45° FOV. 2352 by 1568 pixels. Color fundus image.
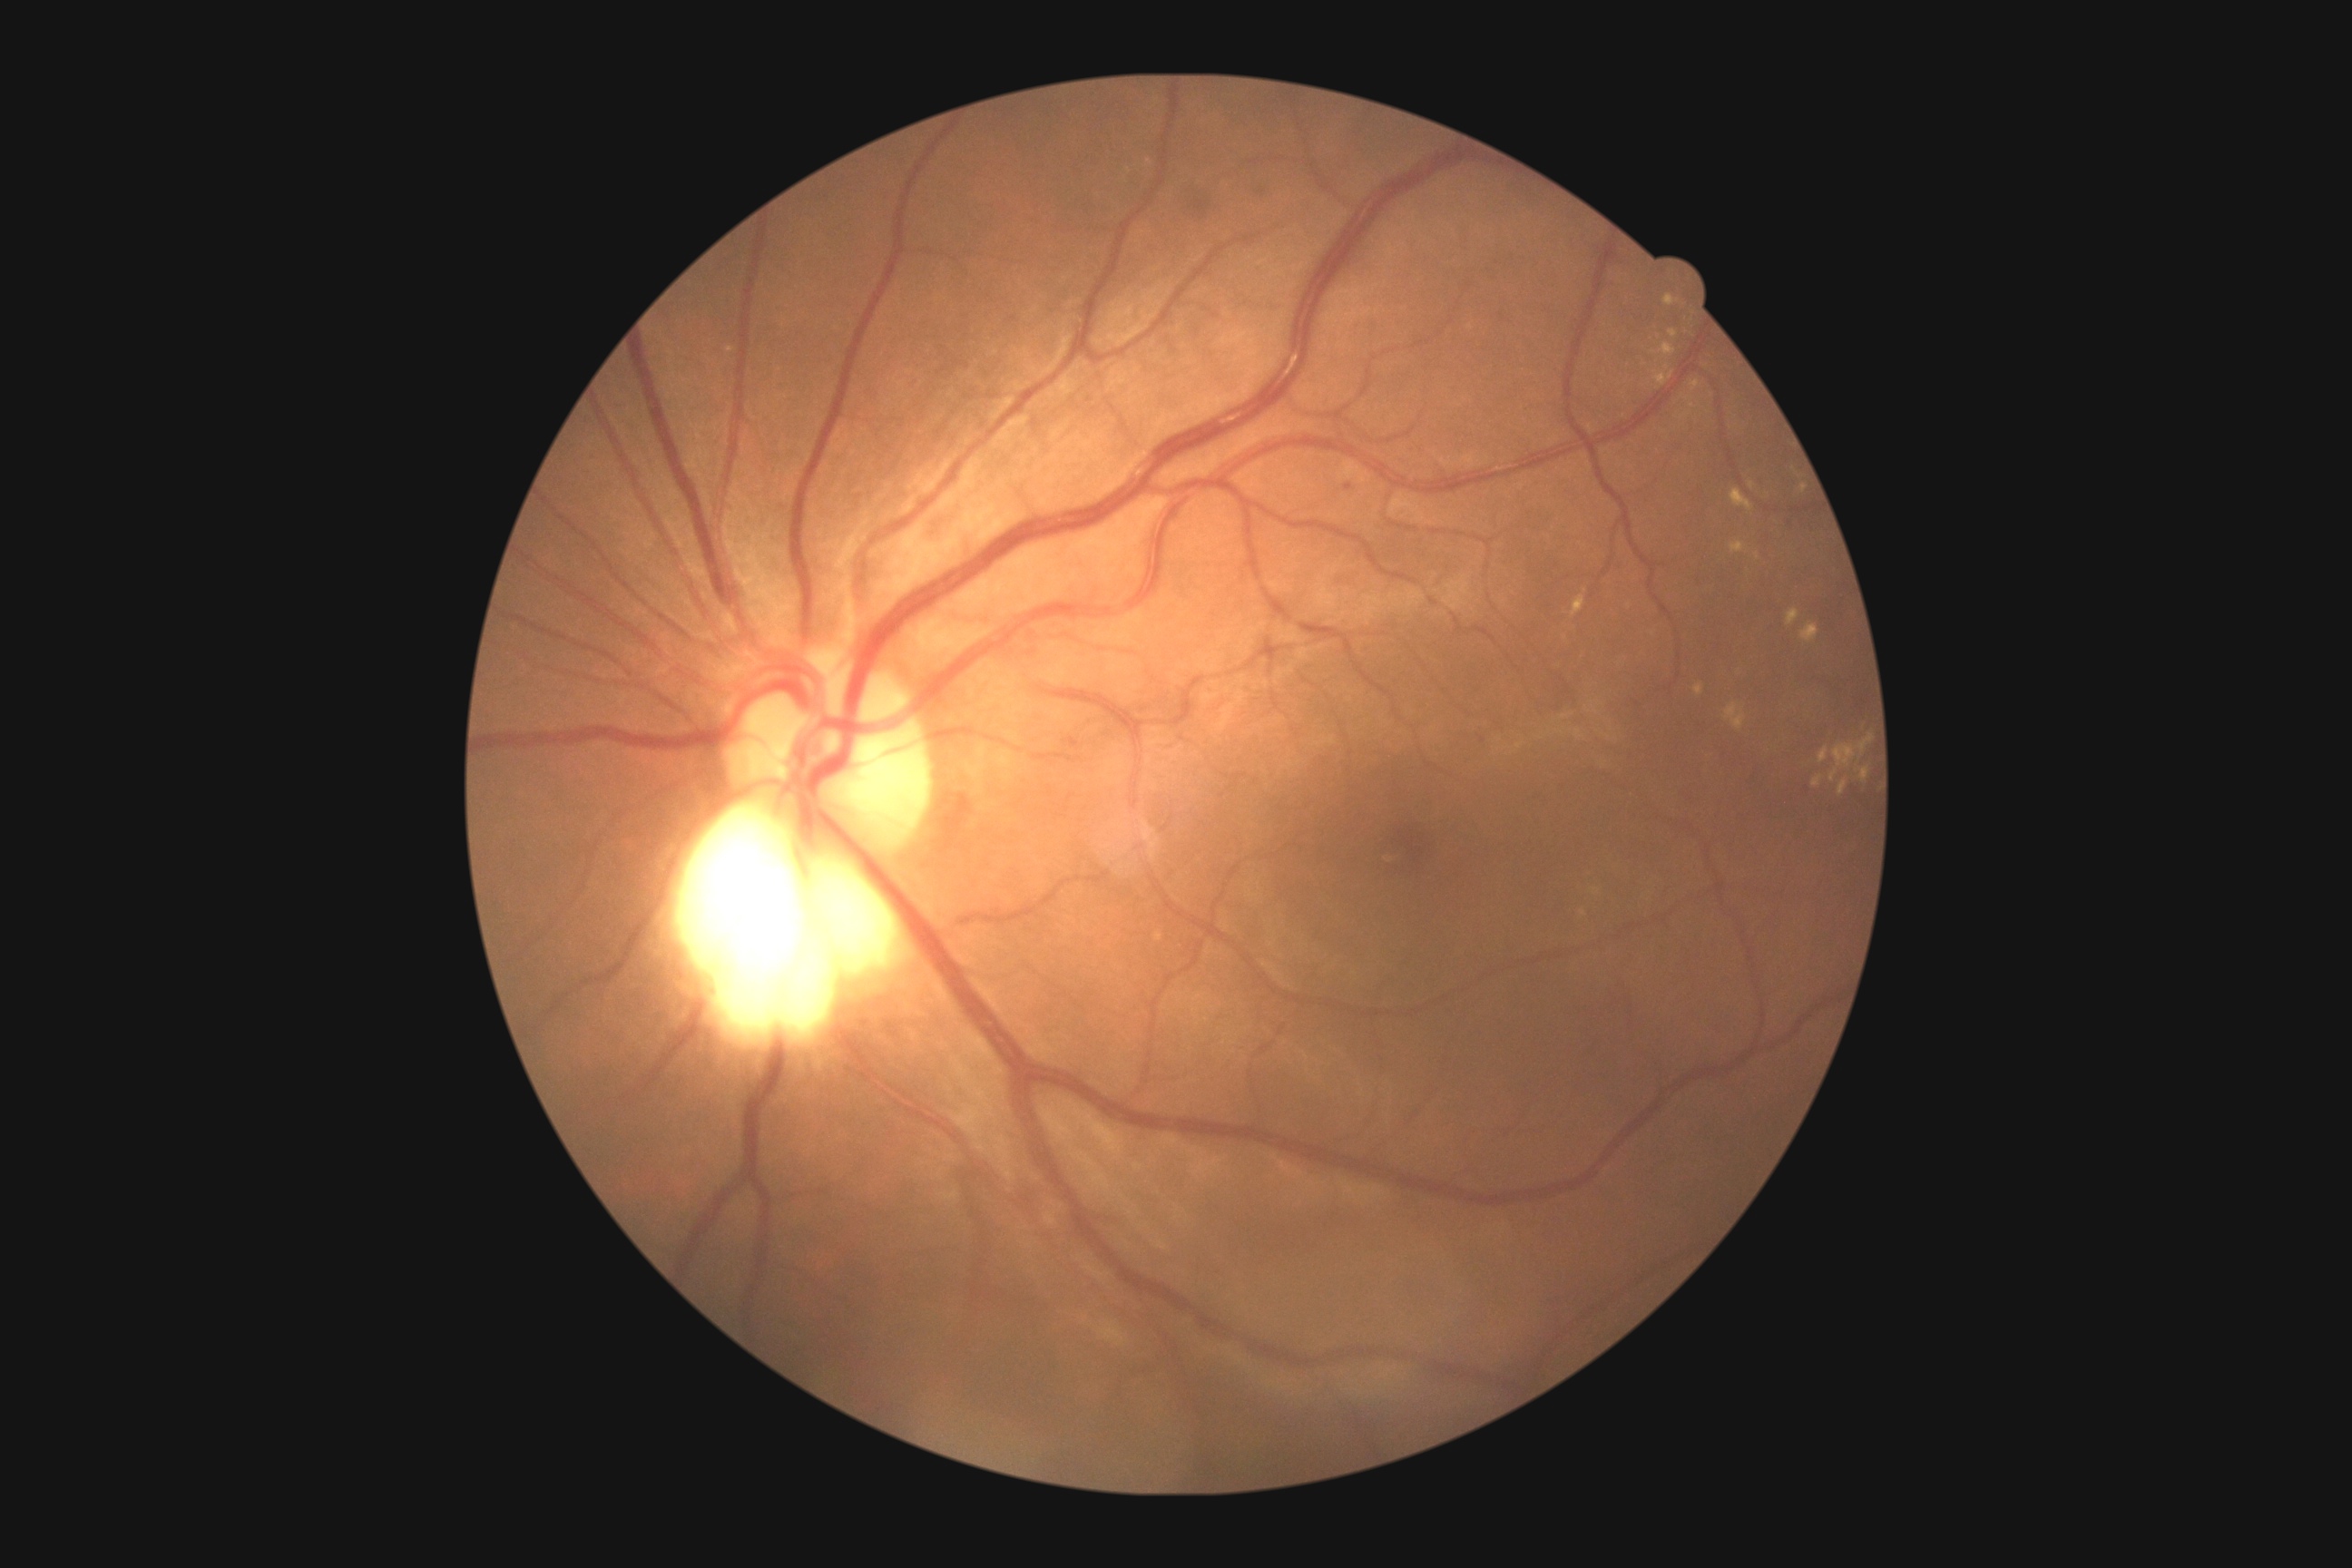
Retinopathy: grade 2 (moderate NPDR)
Selected lesions:
hard exudates (more not shown): x1=1839, y1=781, x2=1848, y2=796 | x1=1861, y1=767, x2=1870, y2=783 | x1=1660, y1=344, x2=1676, y2=357 | x1=1725, y1=703, x2=1747, y2=730 | x1=1690, y1=380, x2=1700, y2=391 | x1=1571, y1=596, x2=1585, y2=618 | x1=1656, y1=366, x2=1674, y2=387 | x1=1730, y1=542, x2=1745, y2=554 | x1=1591, y1=888, x2=1602, y2=896 | x1=1681, y1=413, x2=1689, y2=418
Small hard exudates near x=1758, y=557 | x=1654, y=353 | x=1752, y=485